640 x 480 pixels · wide-field fundus photograph from neonatal ROP screening: 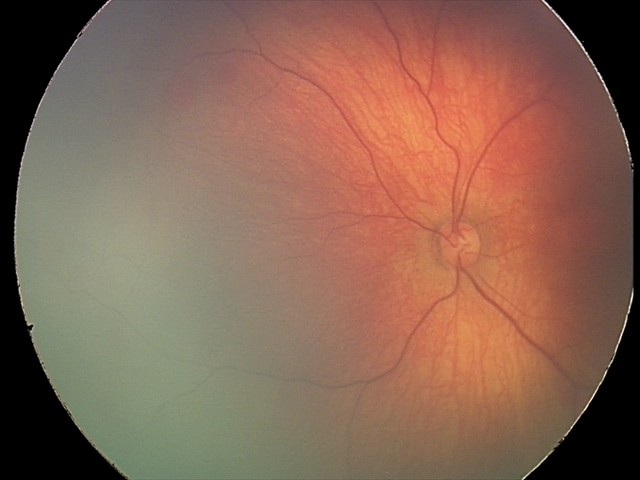
Finding = retinal hemorrhages.